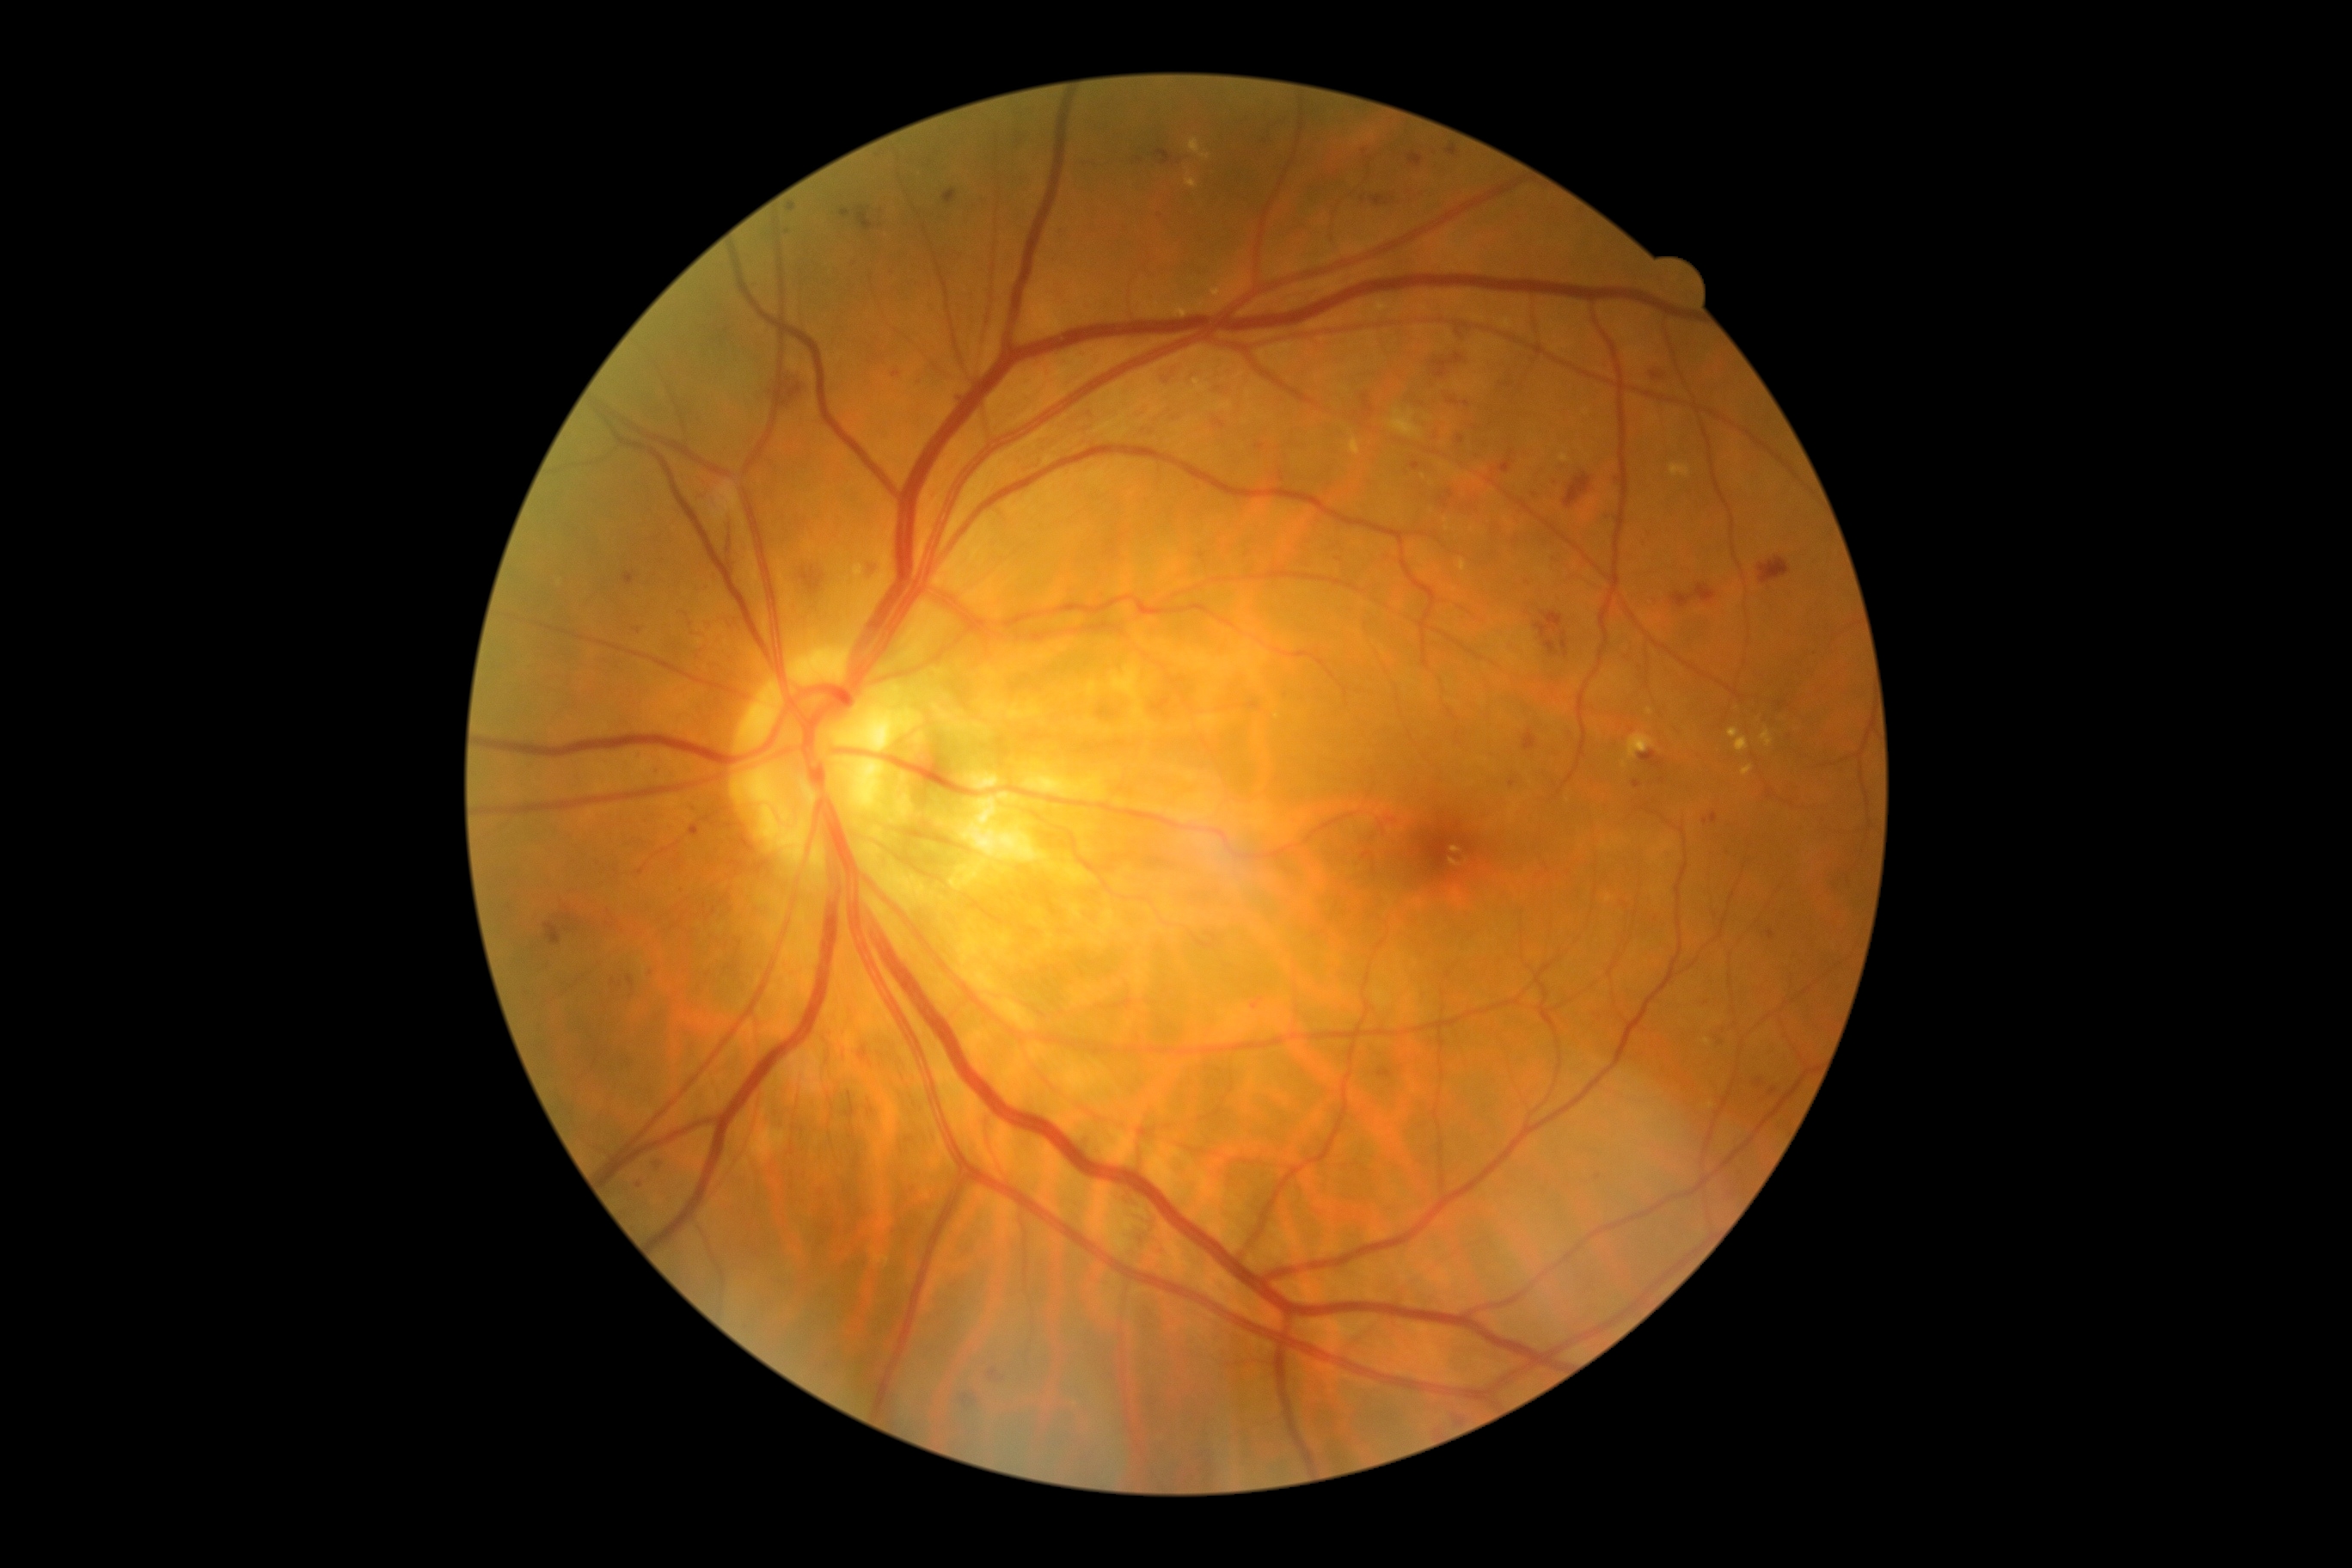 Diabetic retinopathy (DR) is grade 2 (moderate NPDR)
Representative lesions:
microaneurysms (MAs) (continued): [1387, 818, 1397, 823]; [689, 826, 701, 836]; [1371, 195, 1392, 207]; [1767, 931, 1775, 941]; [864, 561, 881, 575]; [893, 371, 900, 379]; [1615, 475, 1622, 484]; [1447, 145, 1461, 157]; [1361, 395, 1375, 420]; [1215, 420, 1227, 429]; [1363, 852, 1373, 859]
MAs (small, approximate centers) near [1662,780]; [967,1397]; [638,631]; [657,1166]; [1608,519]; [1642,544]; [613,983]